Infant wide-field retinal image · 1240x1240
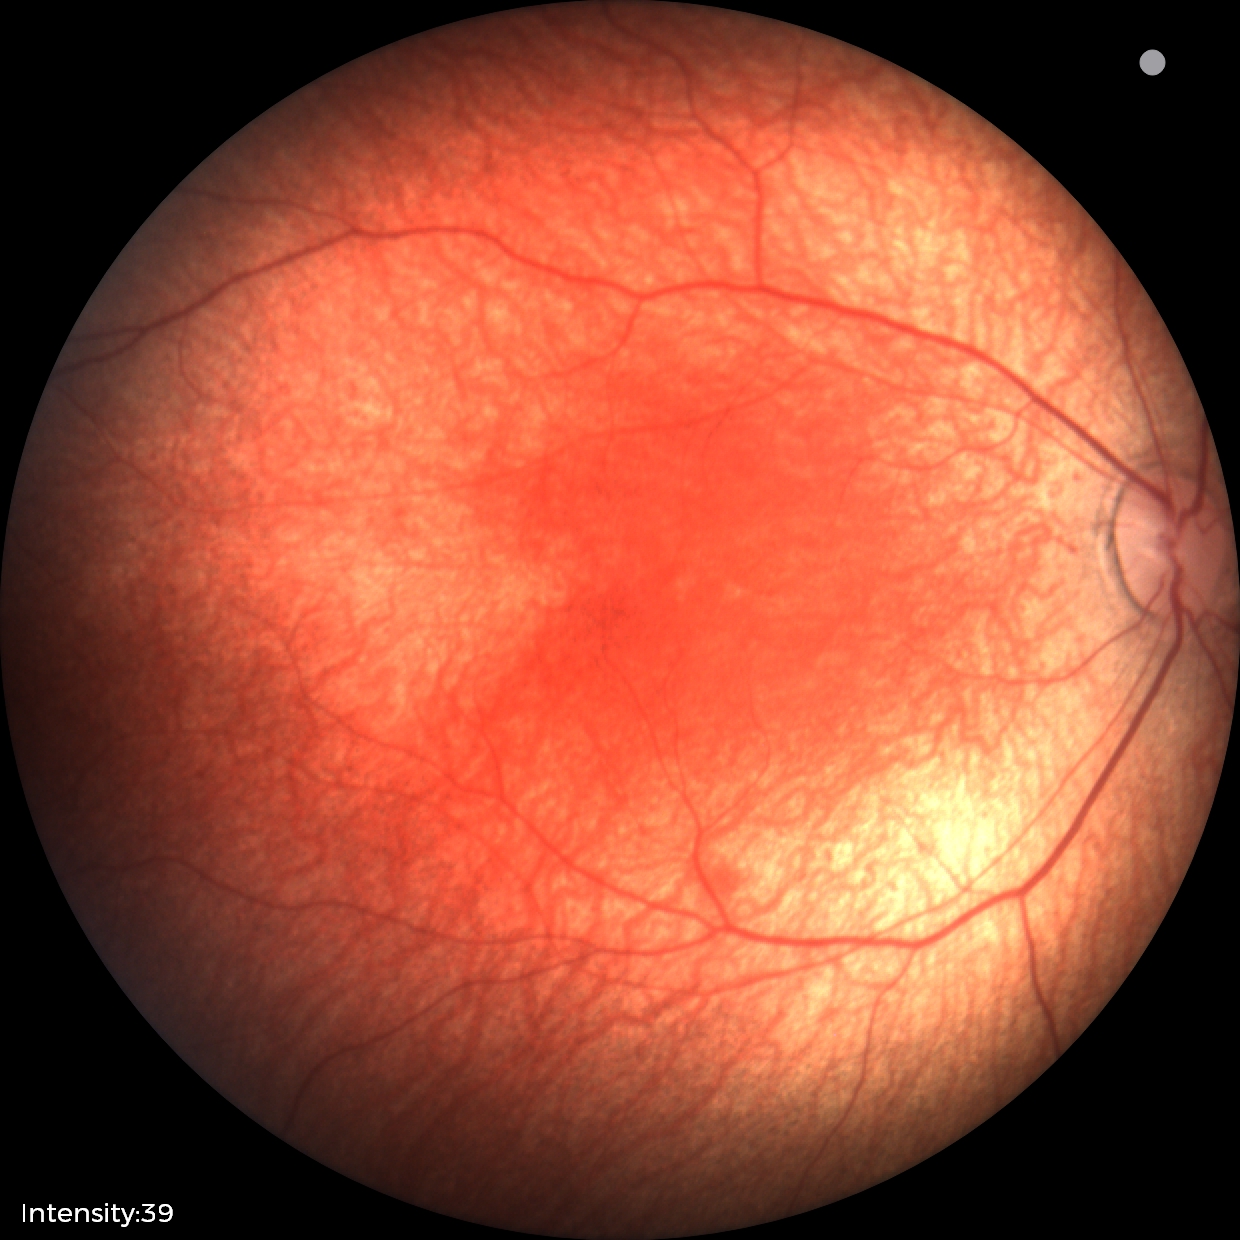
Screening: physiological finding.